Infant wide-field fundus photograph
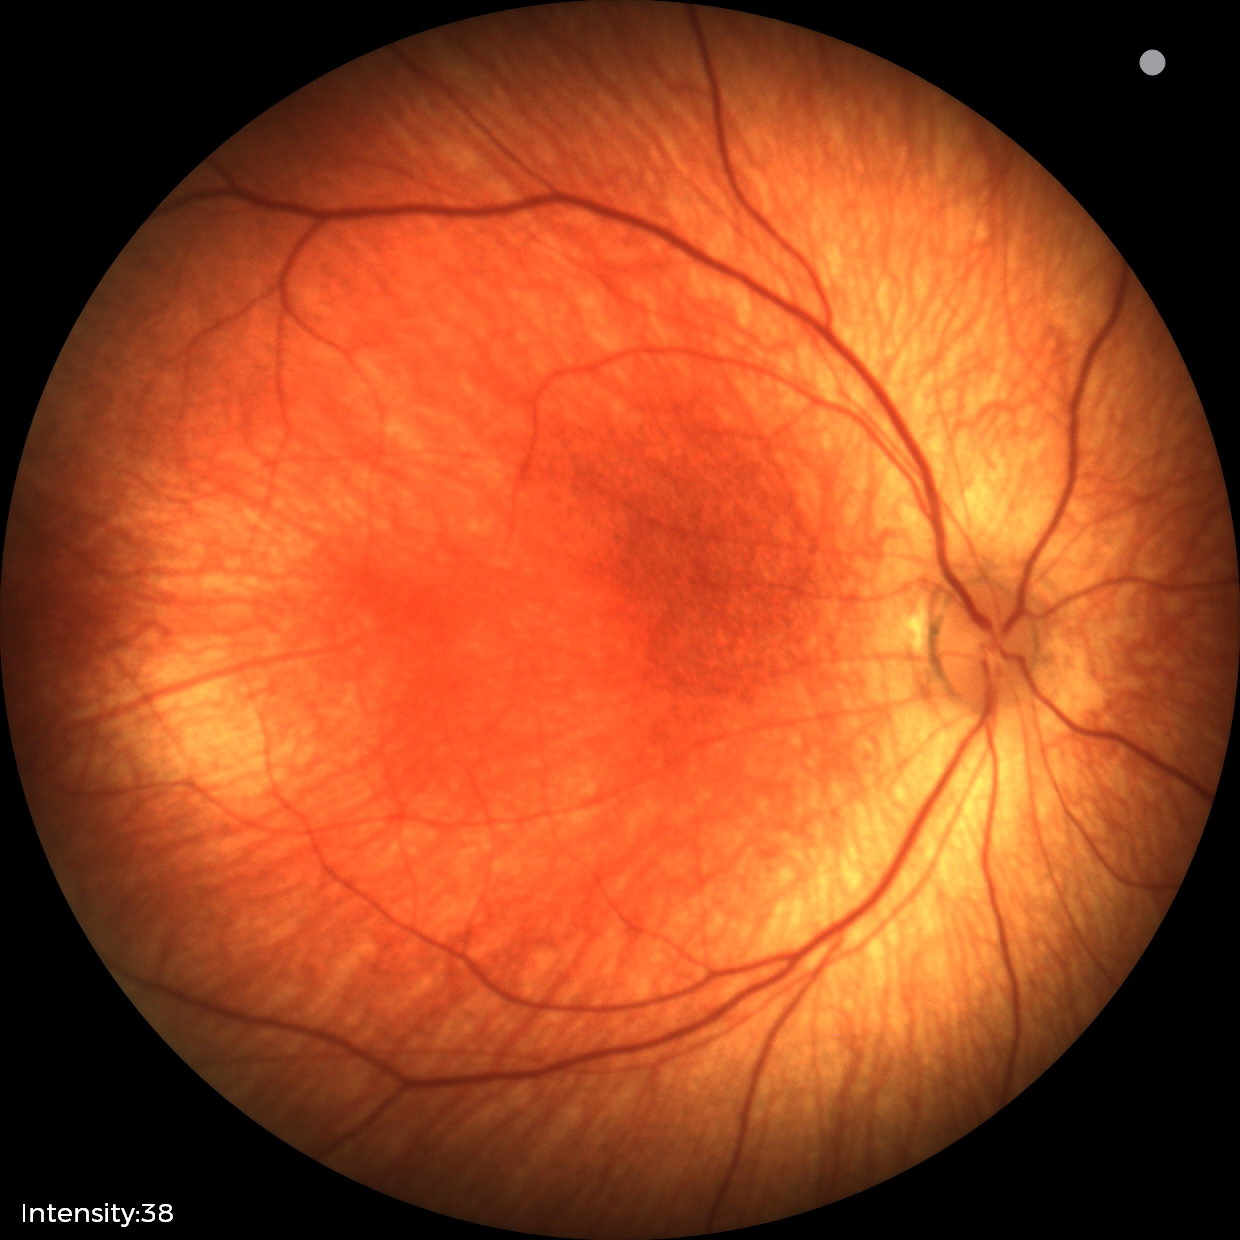

Normal screening examination.